Color fundus image — 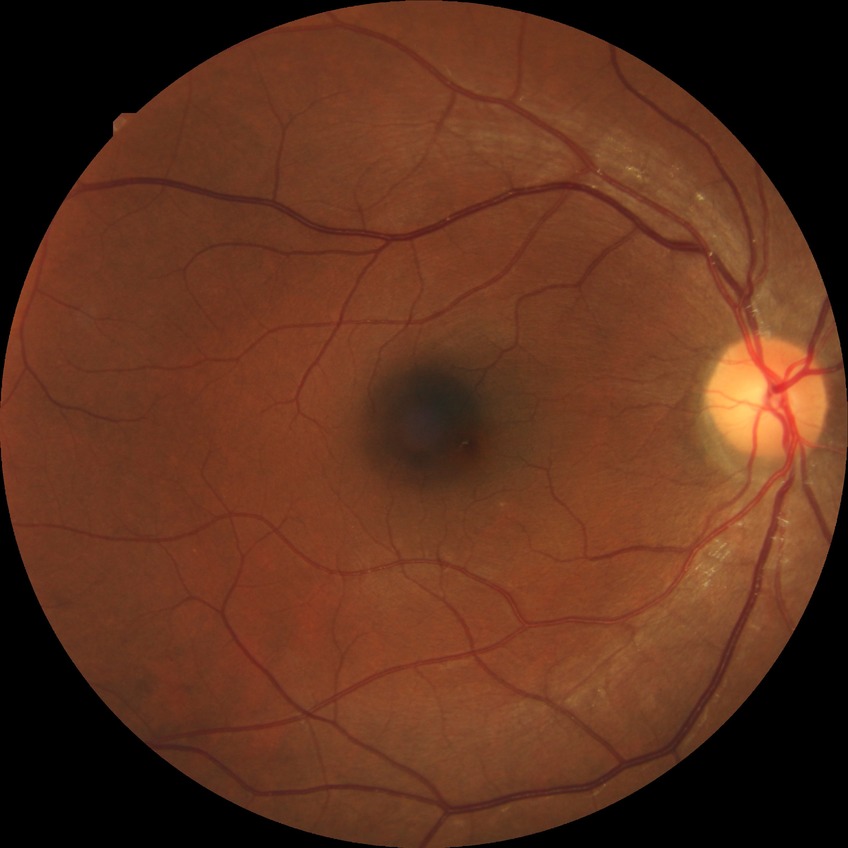
No DR findings. Modified Davis grade is NDR.